Wide-field contact fundus photograph of an infant; image size 1240x1240 — 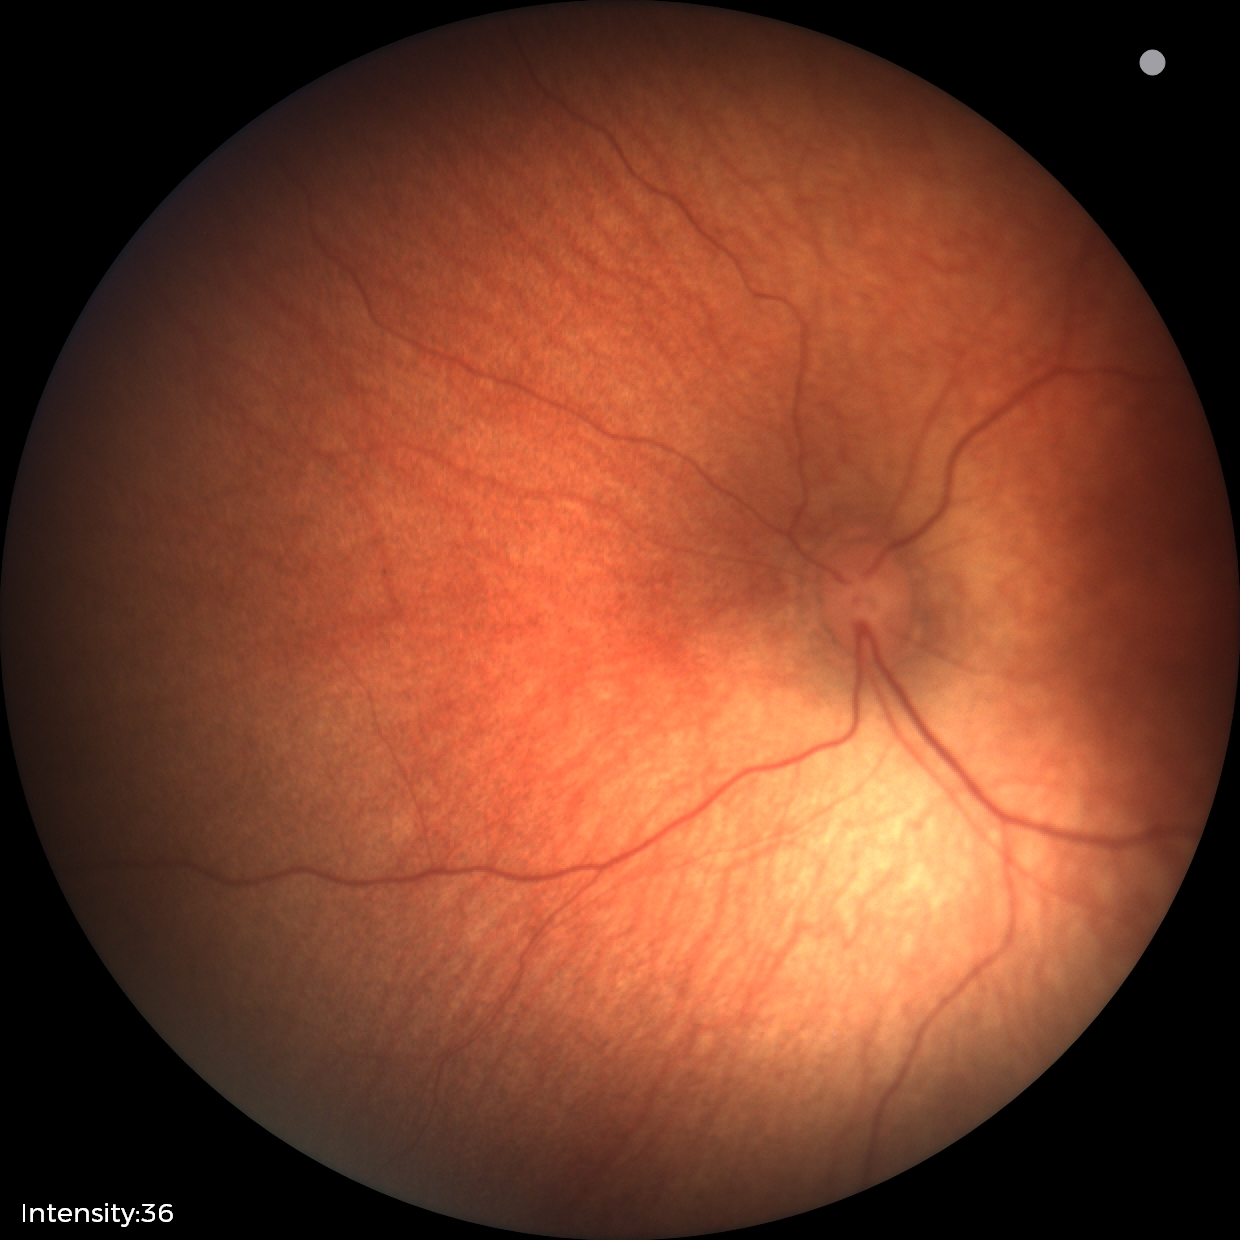 Screening examination with no abnormal retinal findings.